NIDEK AFC-230, without pupil dilation, 45° field of view, 848 x 848 pixels:
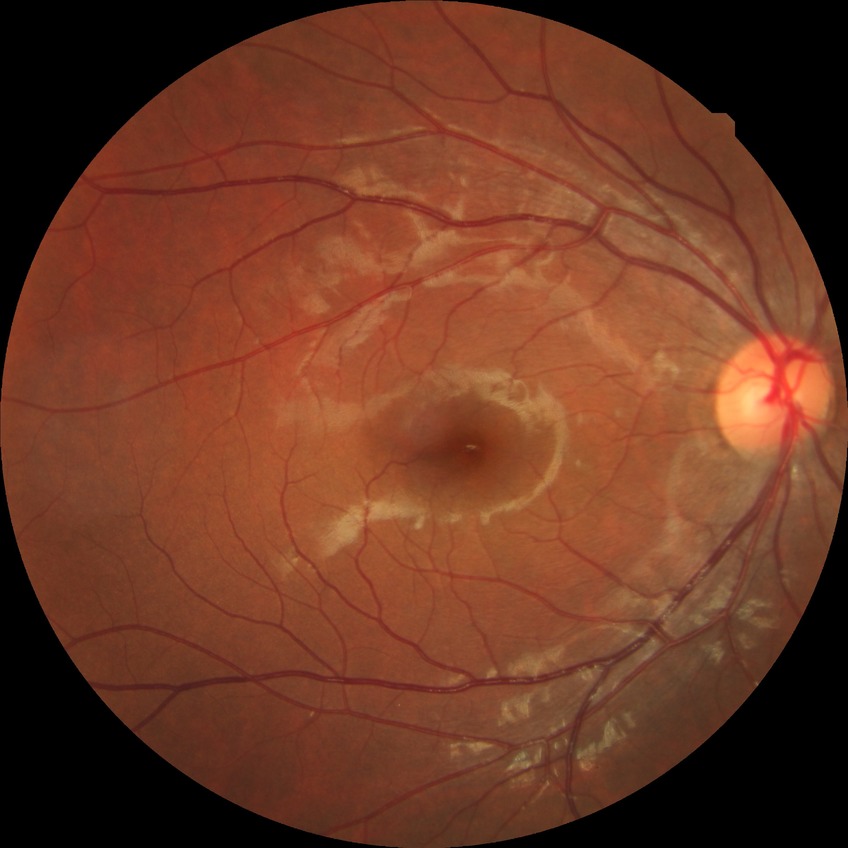

– diabetic retinopathy (DR): NDR (no diabetic retinopathy)